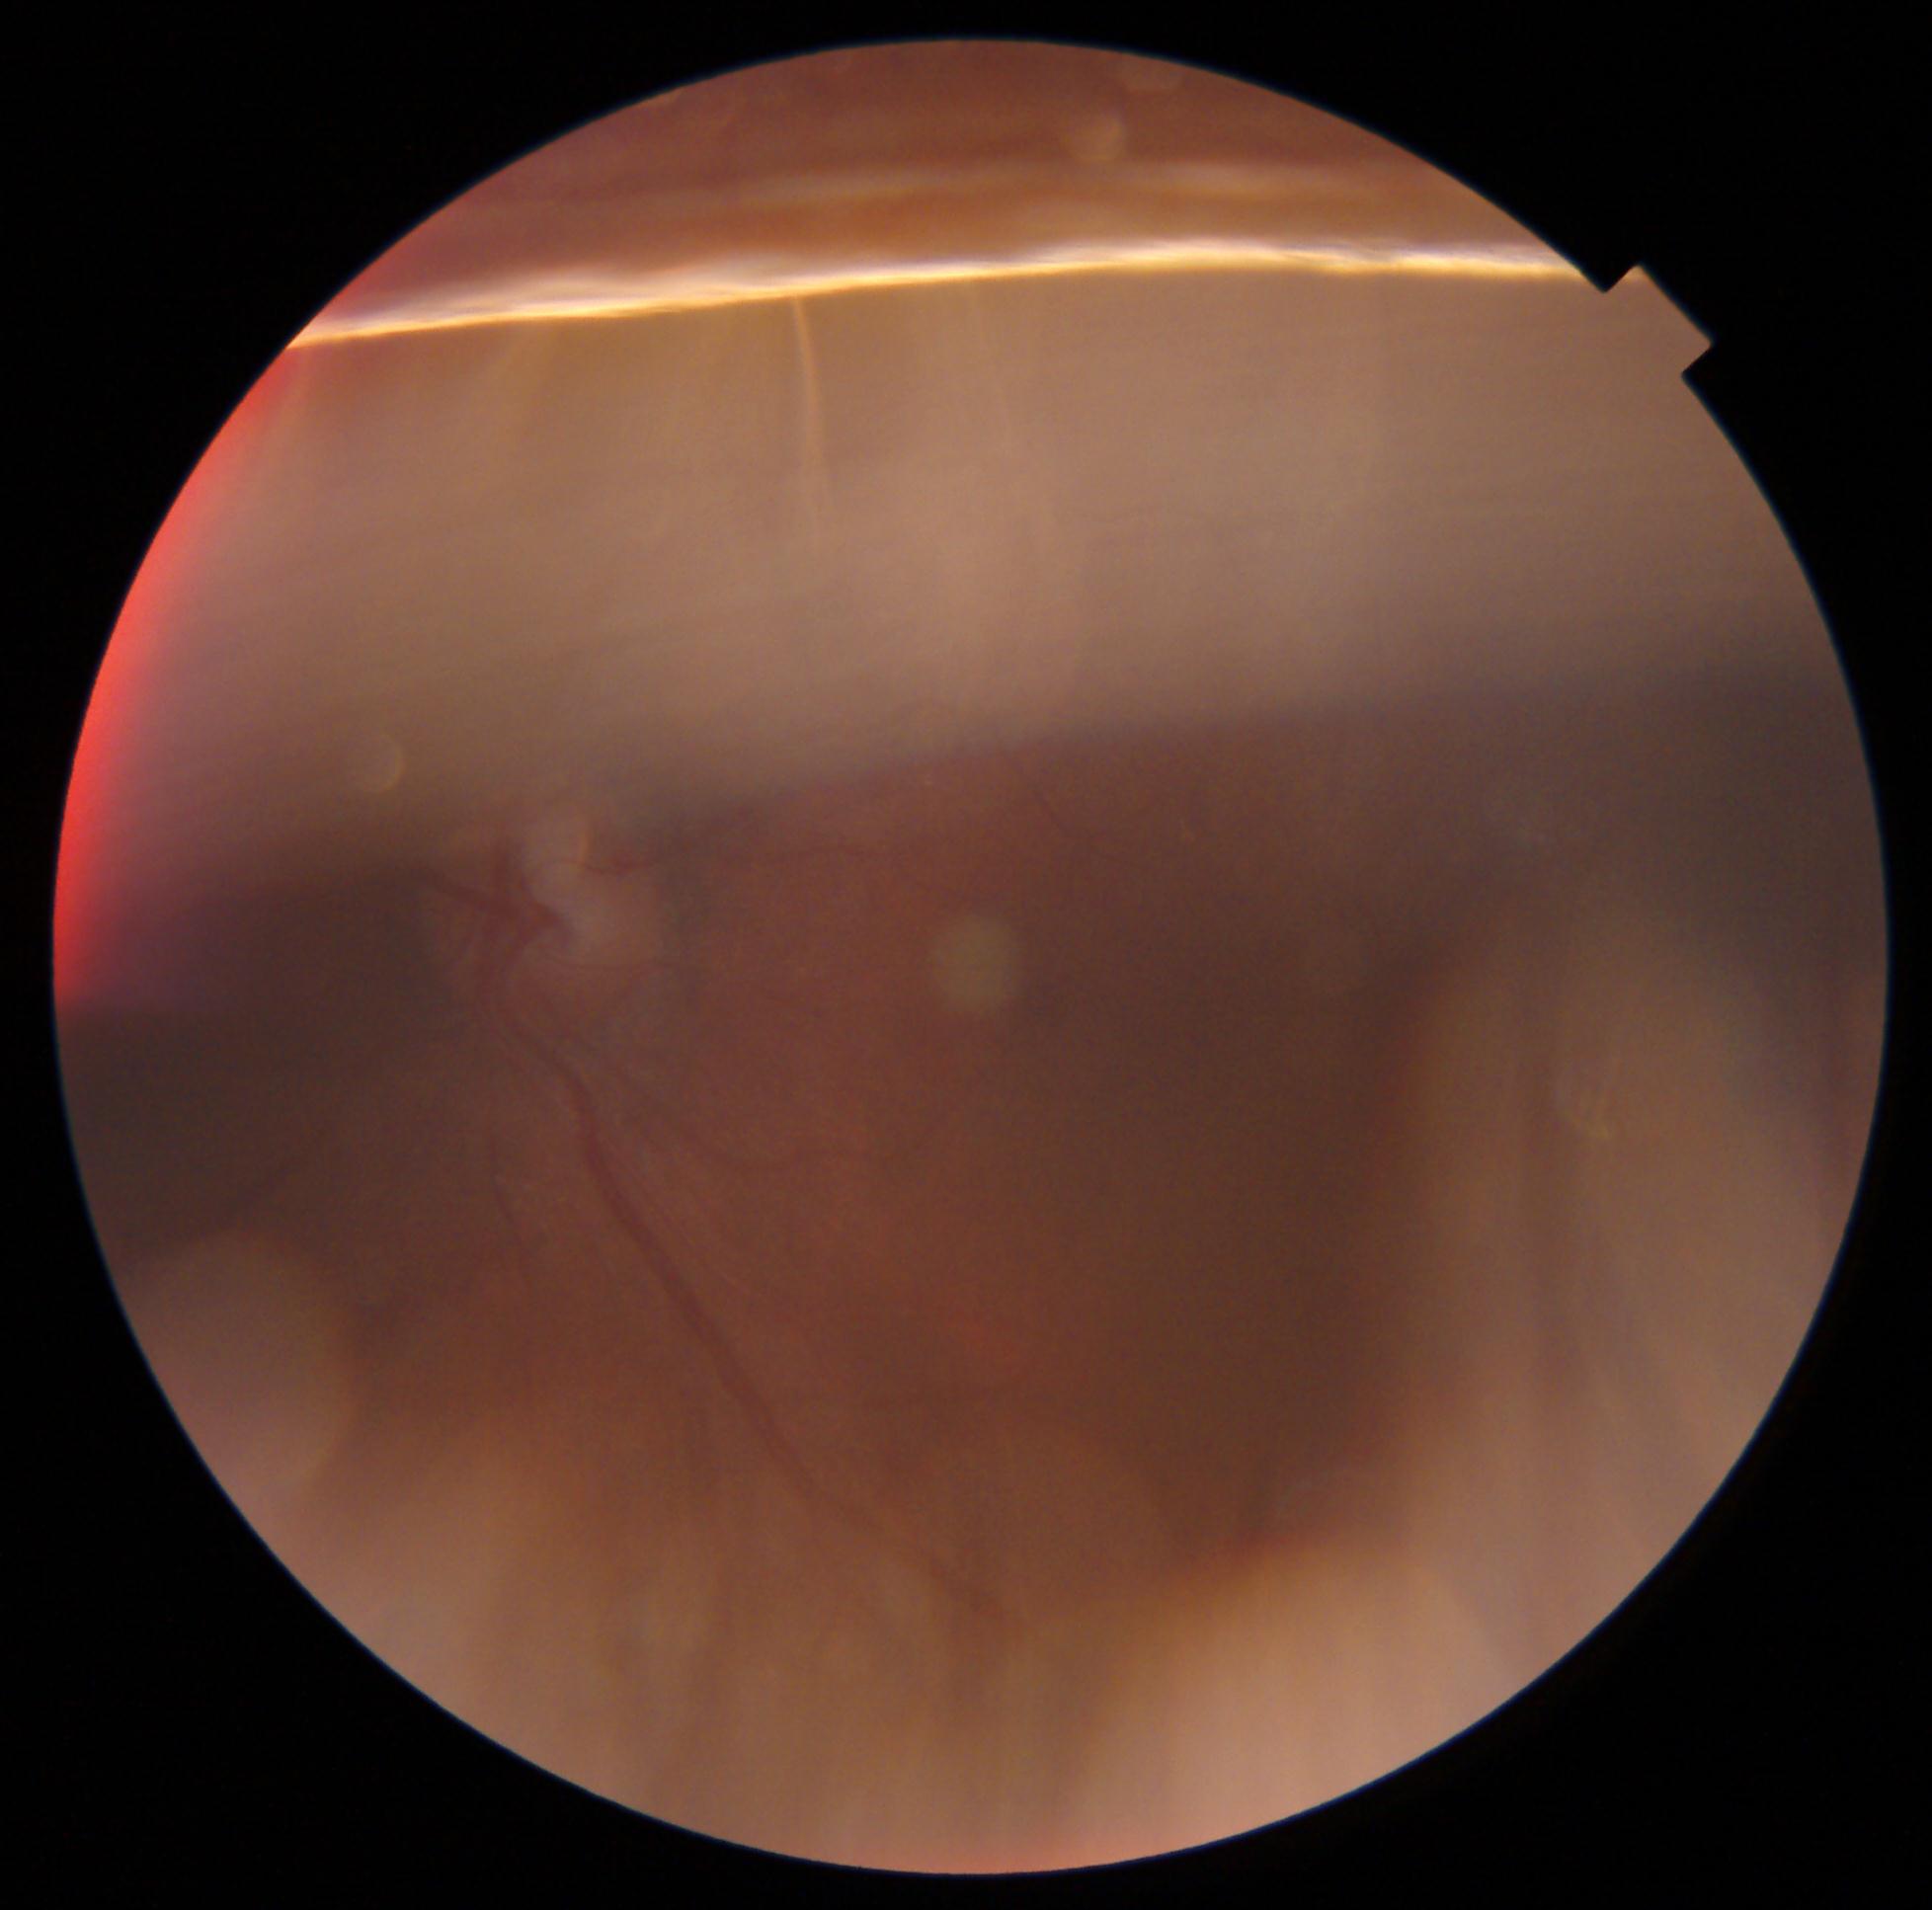

Image quality is insufficient for diabetic retinopathy assessment.
DR grade is ungradable.